Camera: Natus RetCam Envision (130° FOV) · infant wide-field fundus photograph — 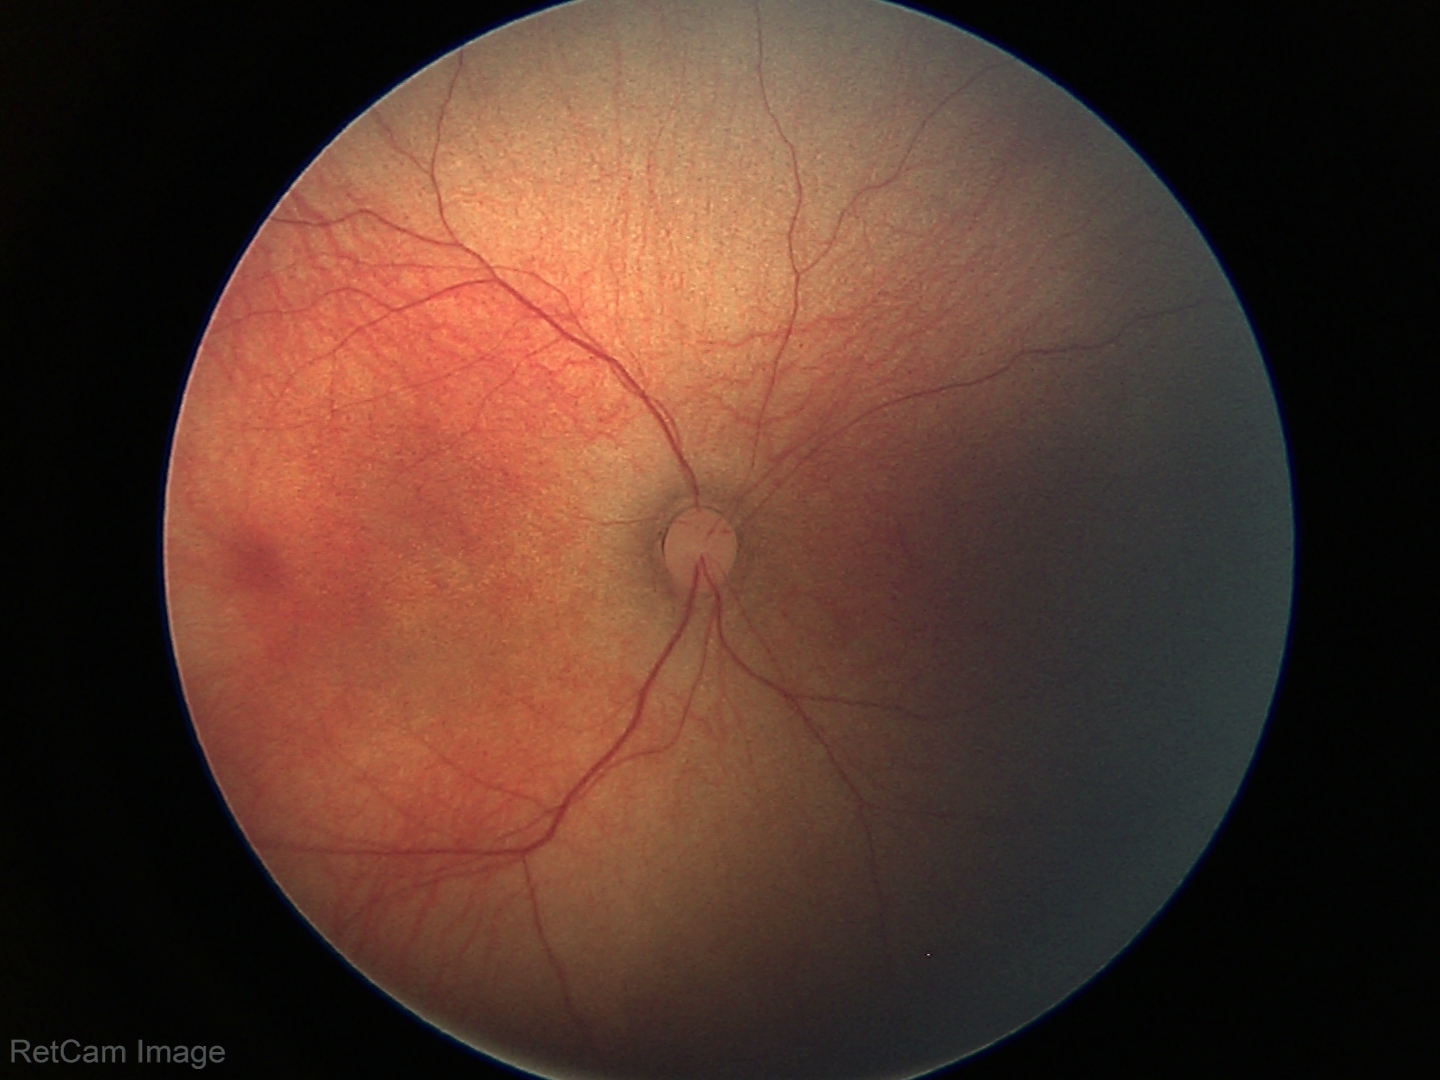 Screening examination with no abnormal retinal findings.